45-degree field of view; without pupil dilation.
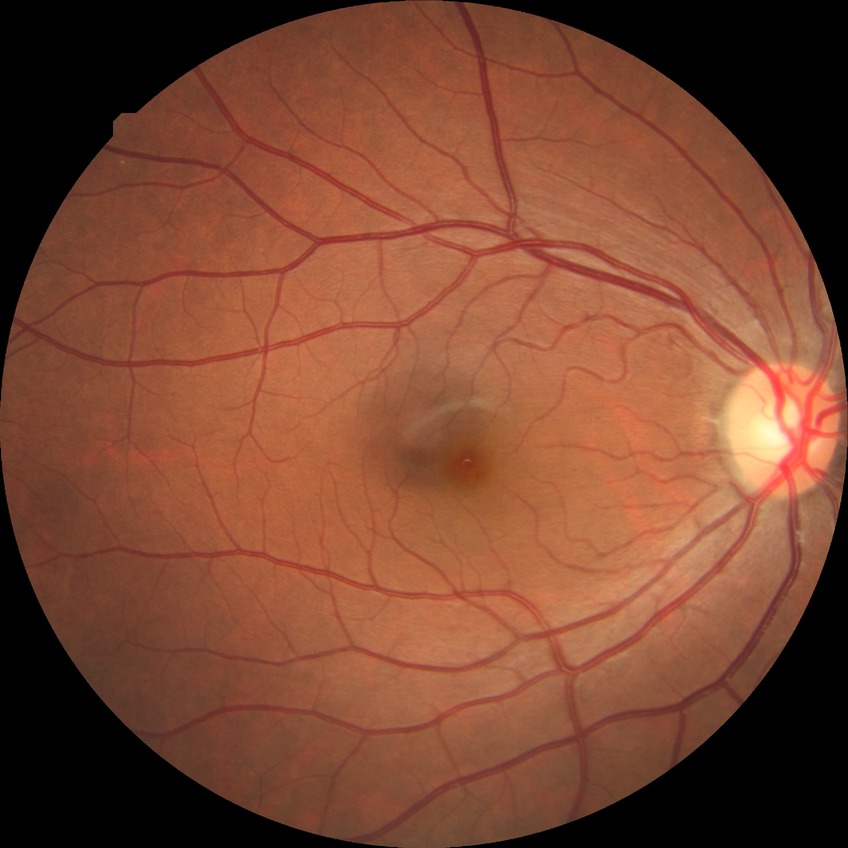
Annotations:
– diabetic retinopathy (DR): no diabetic retinopathy (NDR)